45-degree field of view.
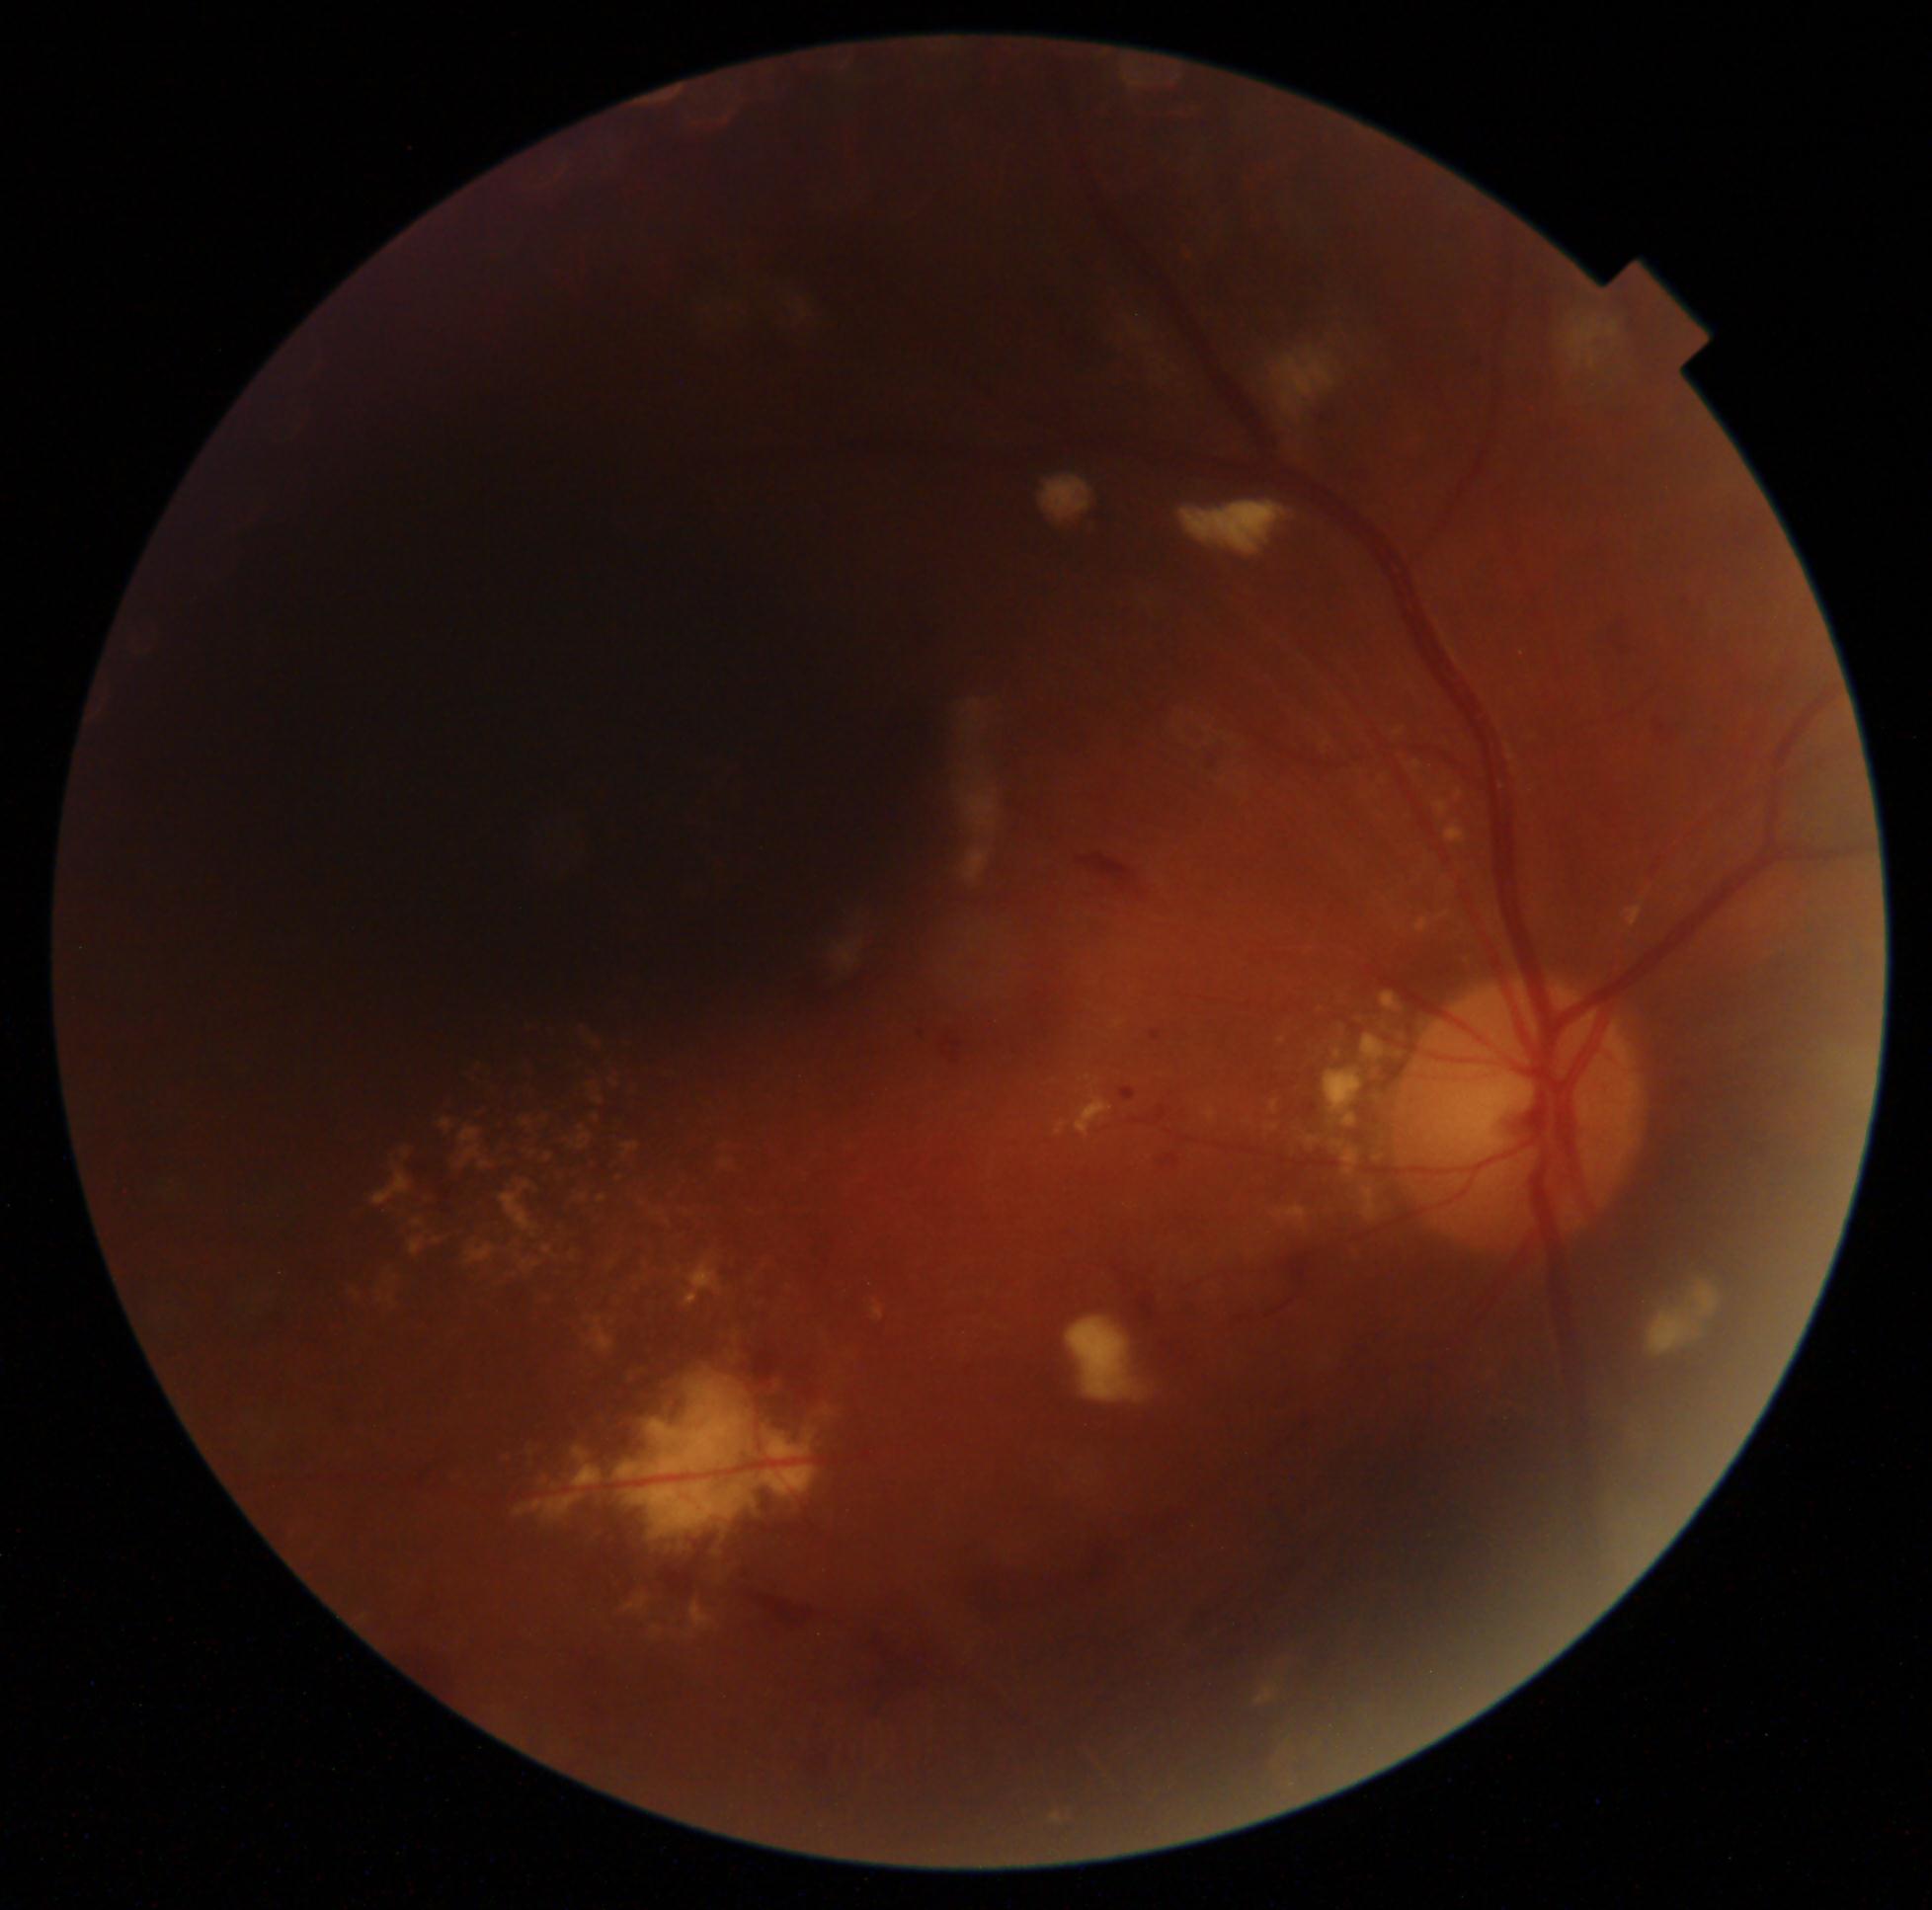 - DR class — non-proliferative diabetic retinopathy
- DR grade — 2 (moderate NPDR)